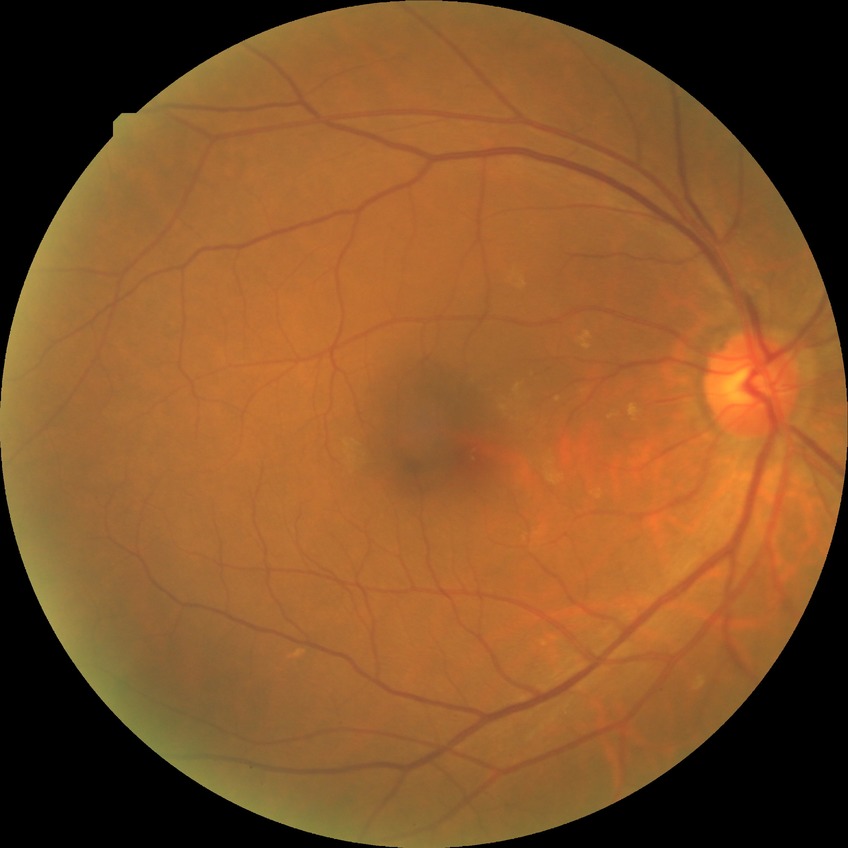
davis_grade: NDR